Captured with the Clarity RetCam 3 (130° field of view) · infant wide-field fundus photograph · 640 by 480 pixels
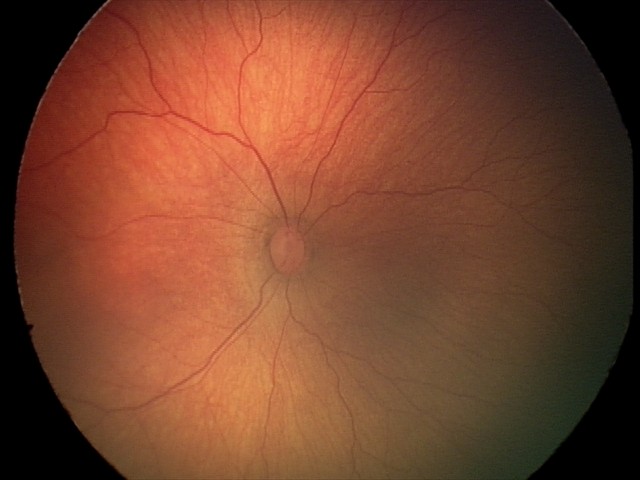

No plus disease. From an examination with diagnosis of retinopathy of prematurity stage 2.